Acquired with a Topcon TRC-50DX, pupil-dilated: 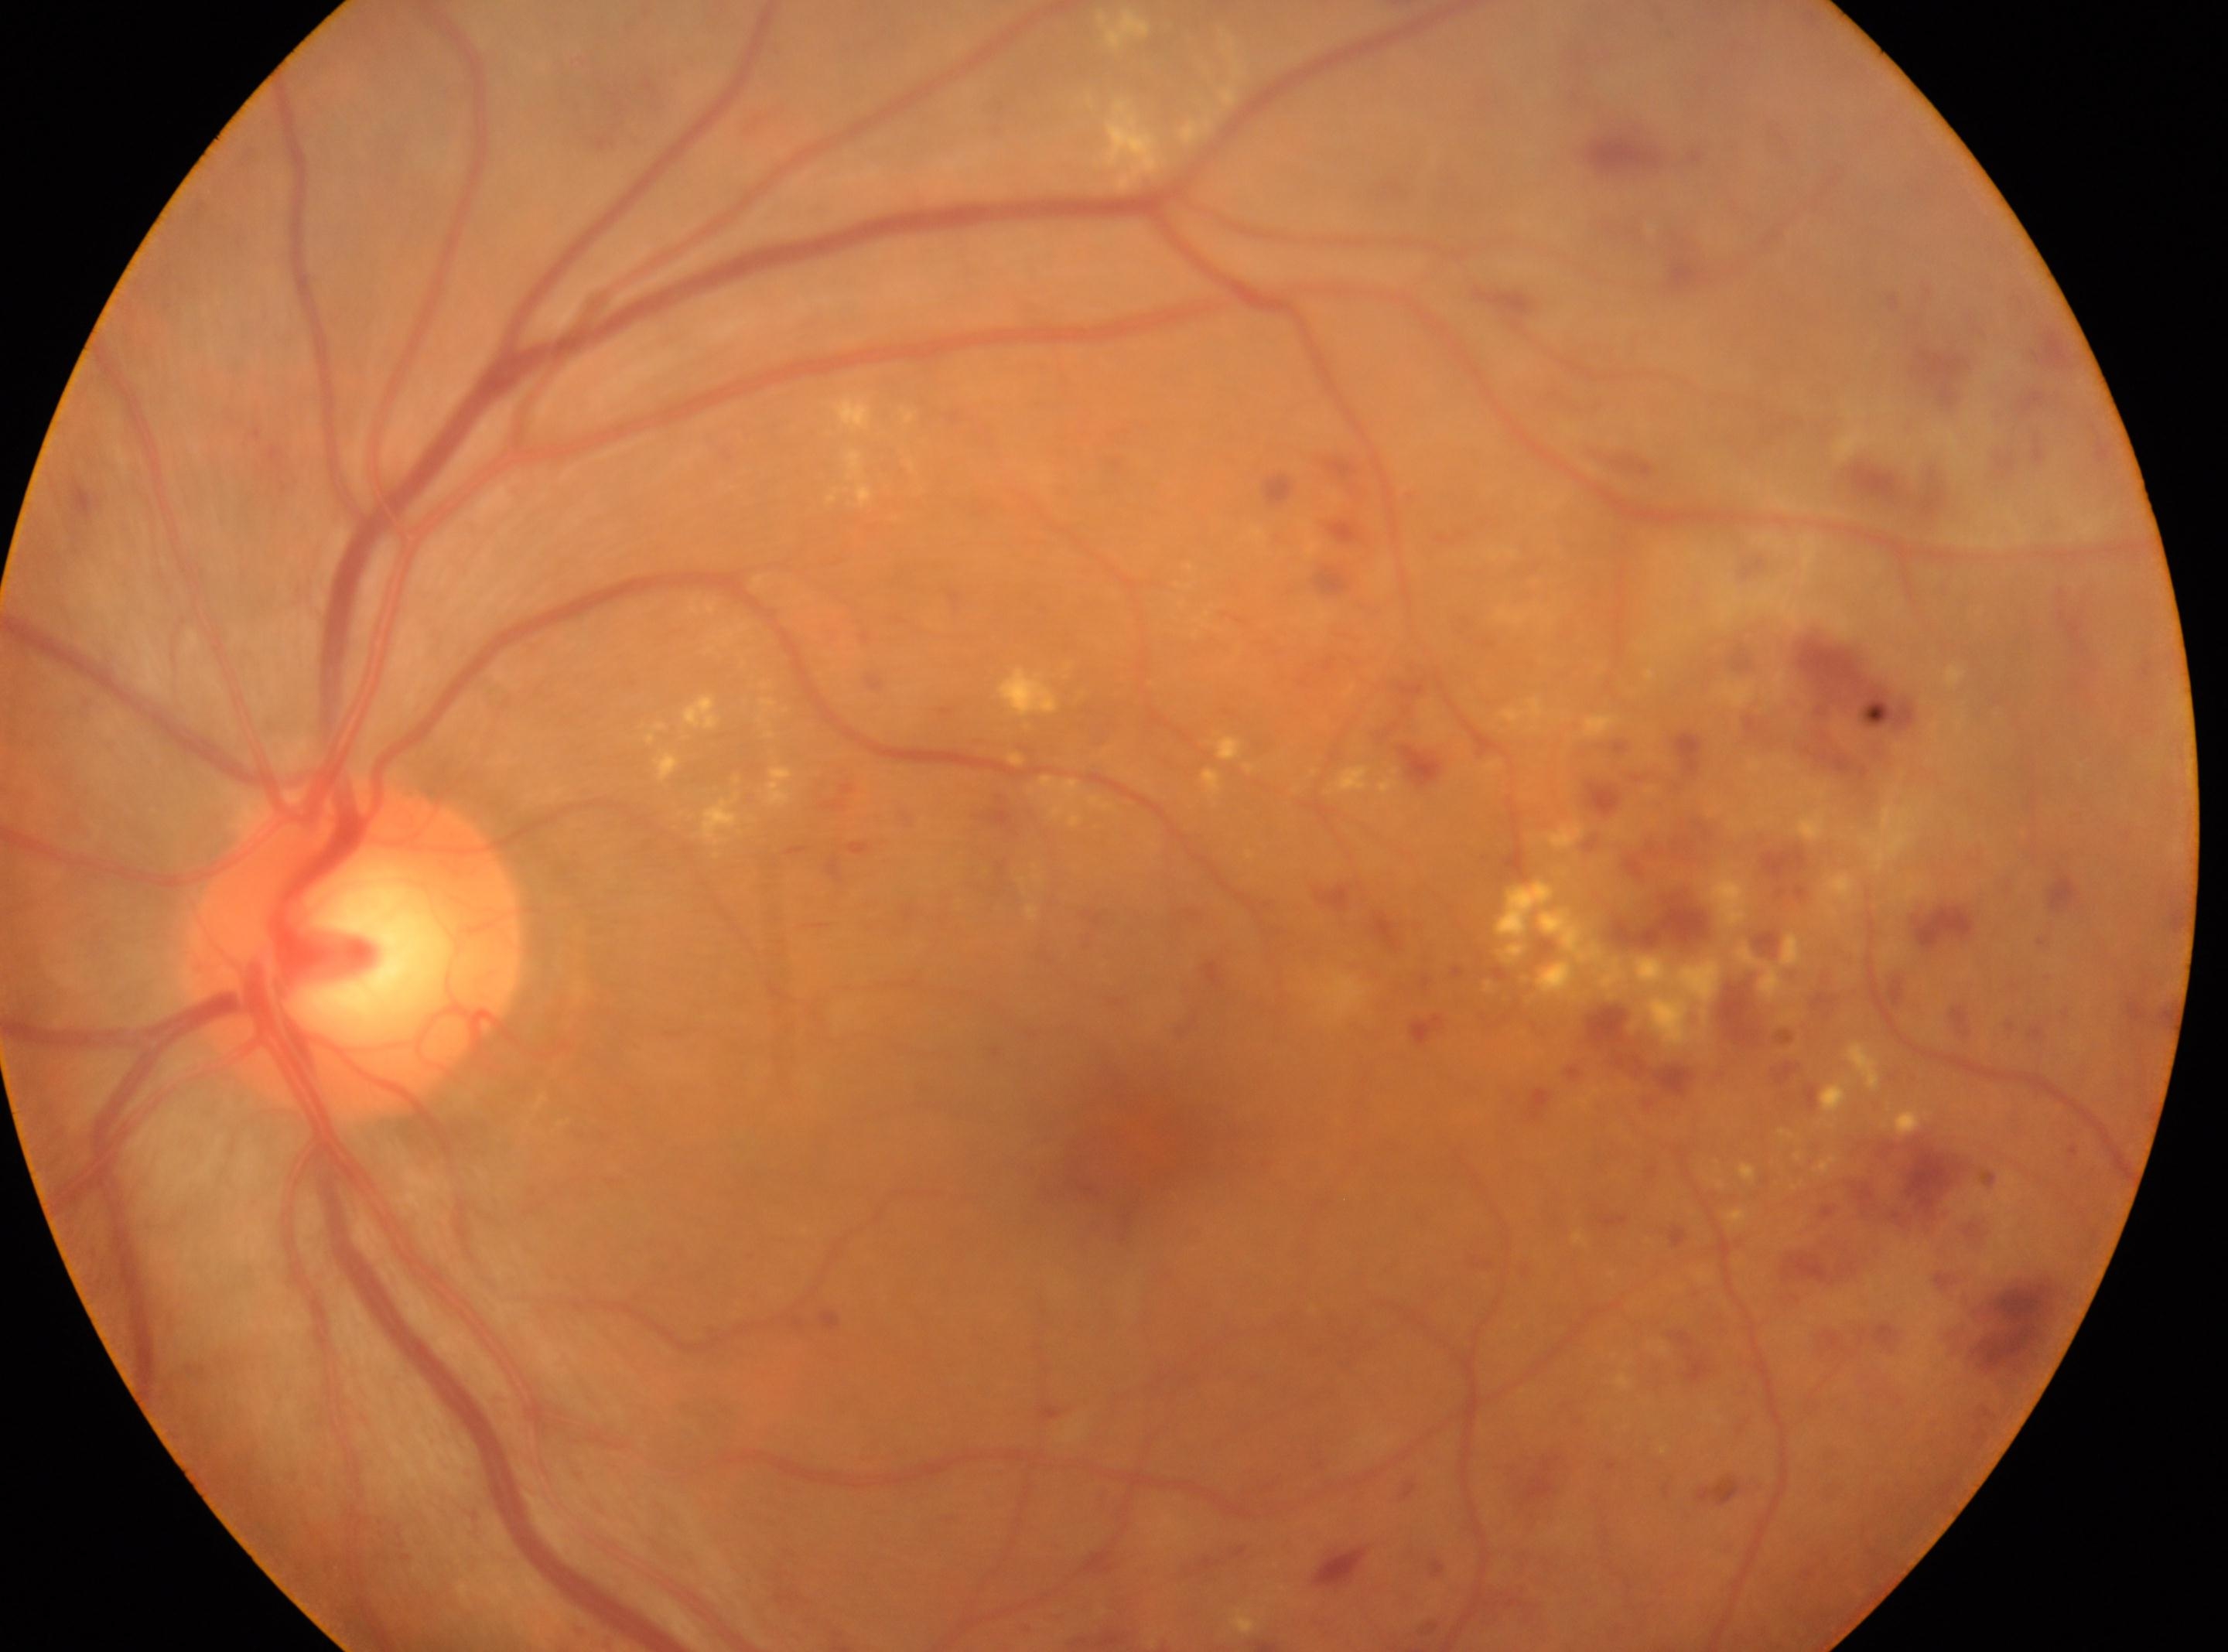

{"eye": "oculus sinister", "dr_grade": "3 (severe NPDR)", "optic_disc": "354, 951", "fovea": "1122, 1140"}